2048x1536px · fundus photo:
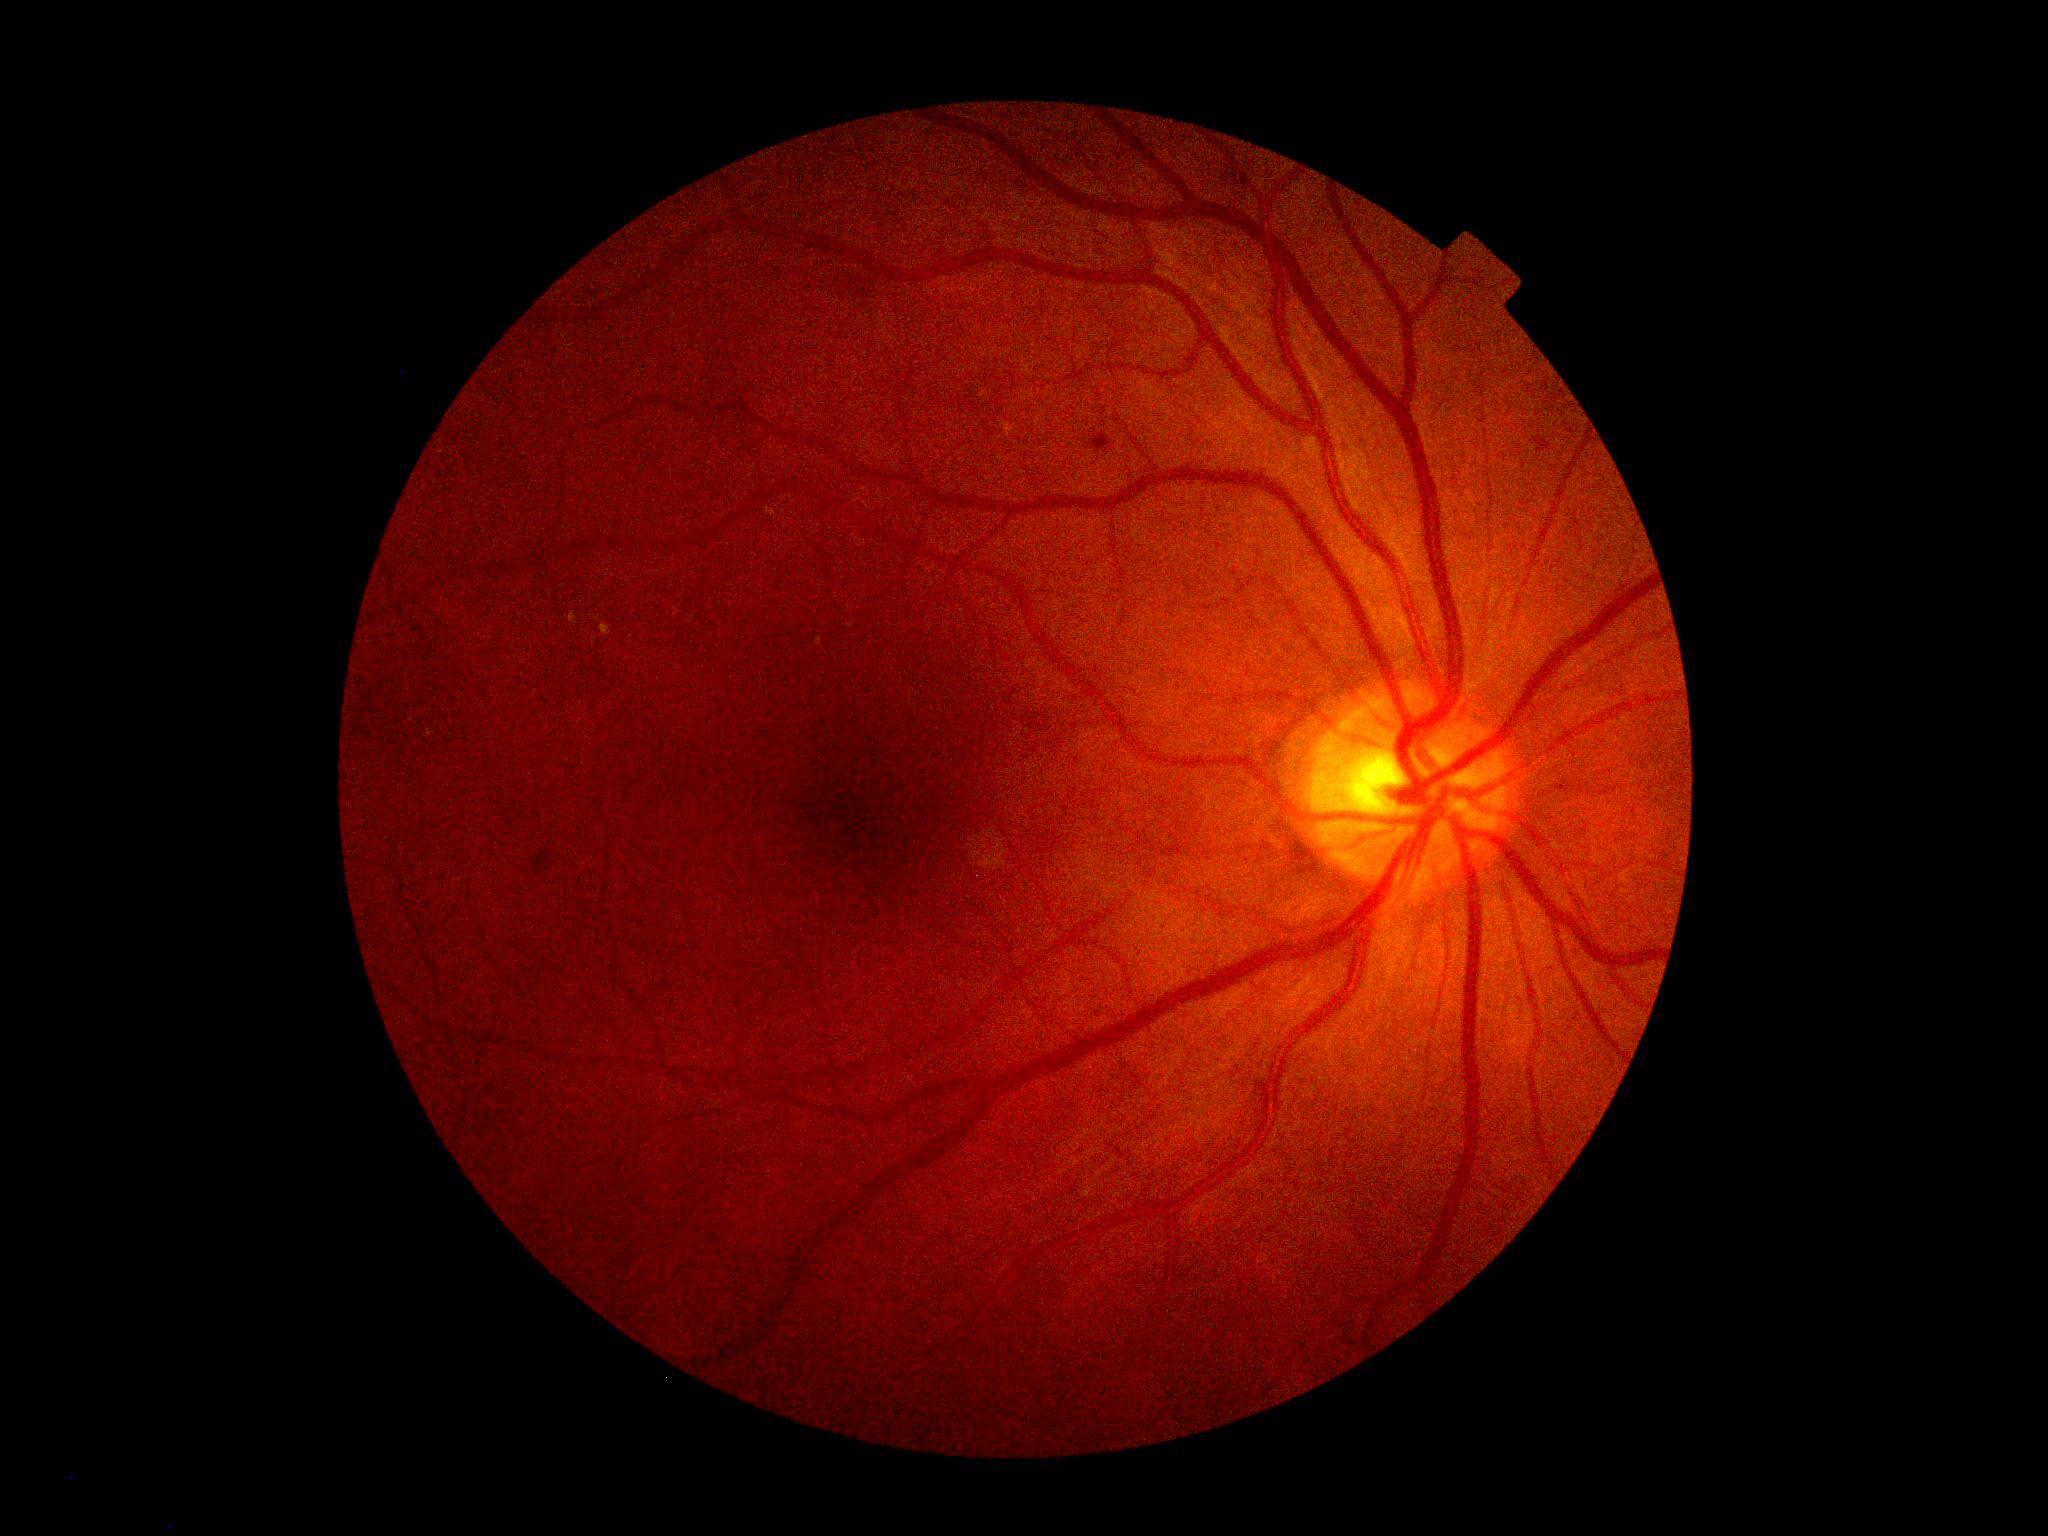
diabetic retinopathy severity = grade 2 (moderate NPDR)